Color fundus image:
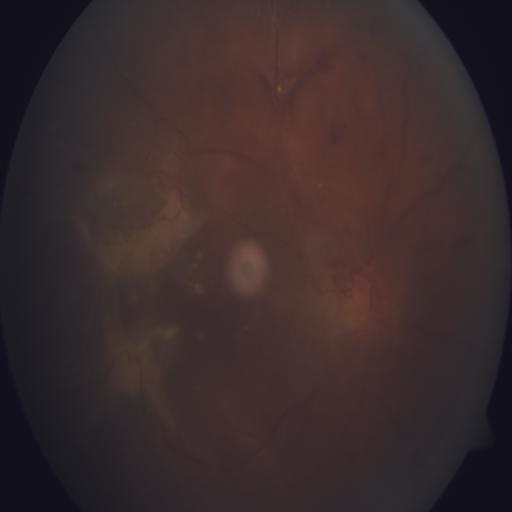

Demonstrates preretinal hemorrhage, retinal traction & hemorrhagic retinopathy.